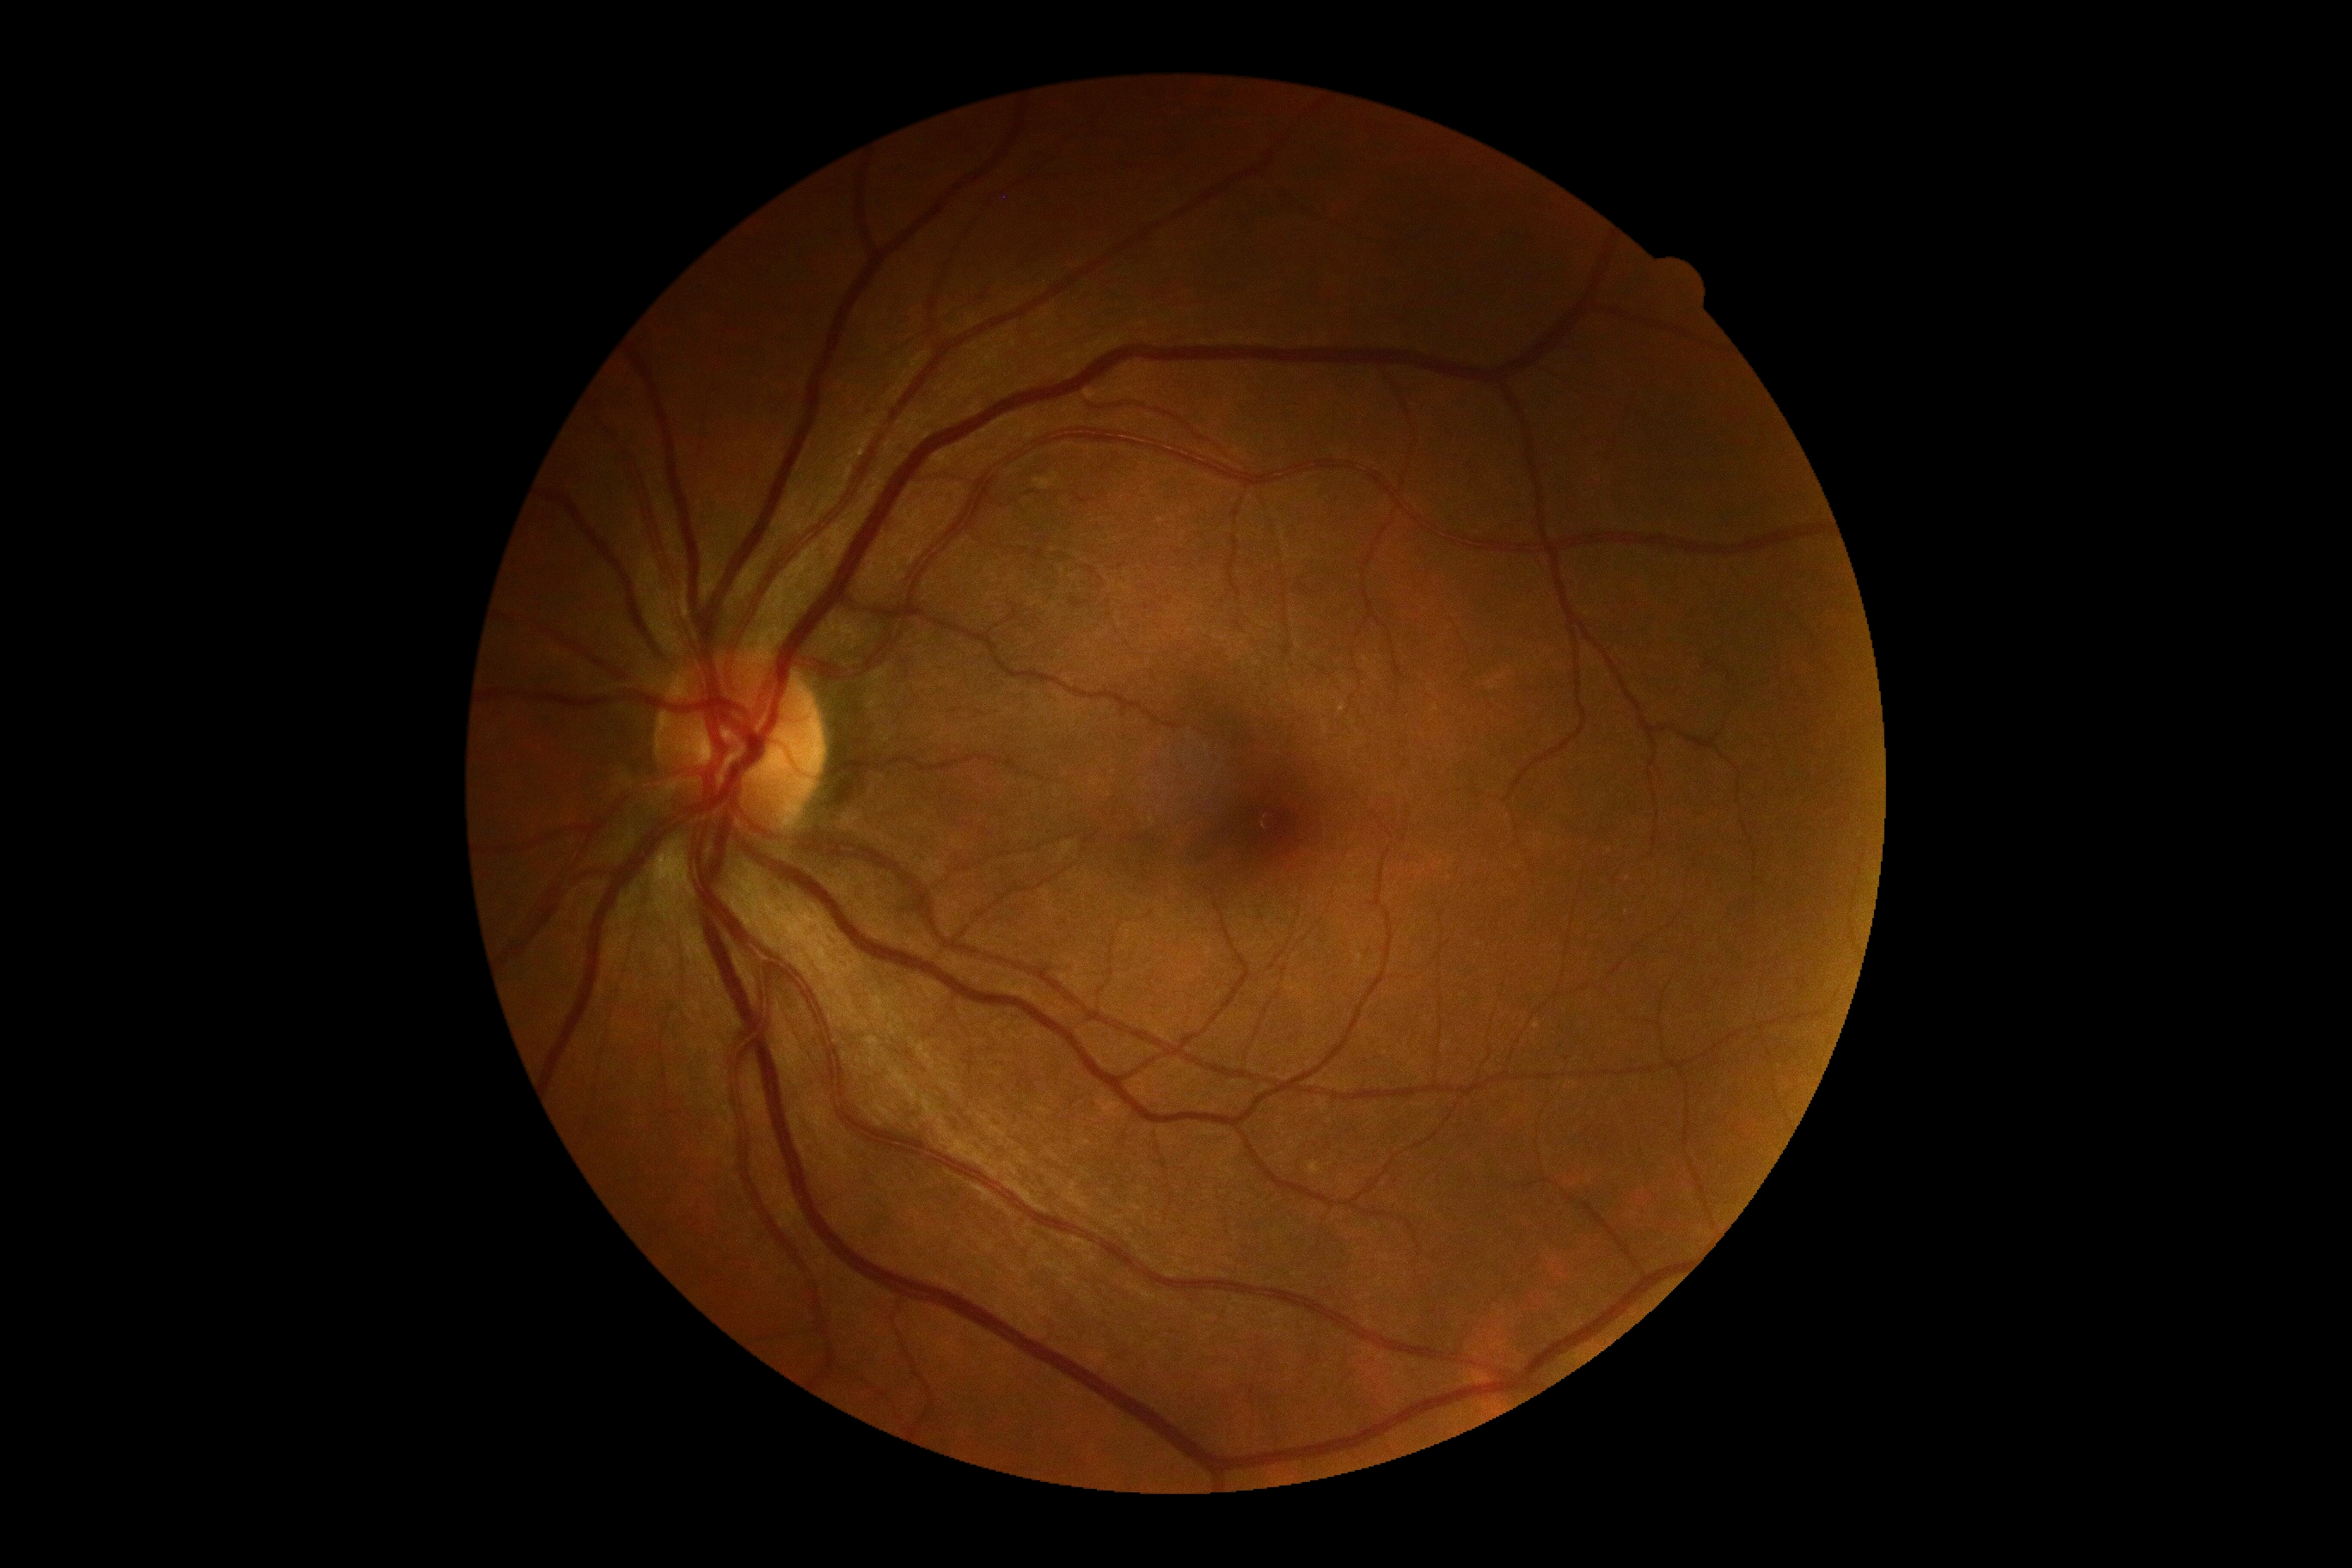 No diabetic retinal disease findings. Diabetic retinopathy (DR) is grade 0 — no visible signs of diabetic retinopathy.